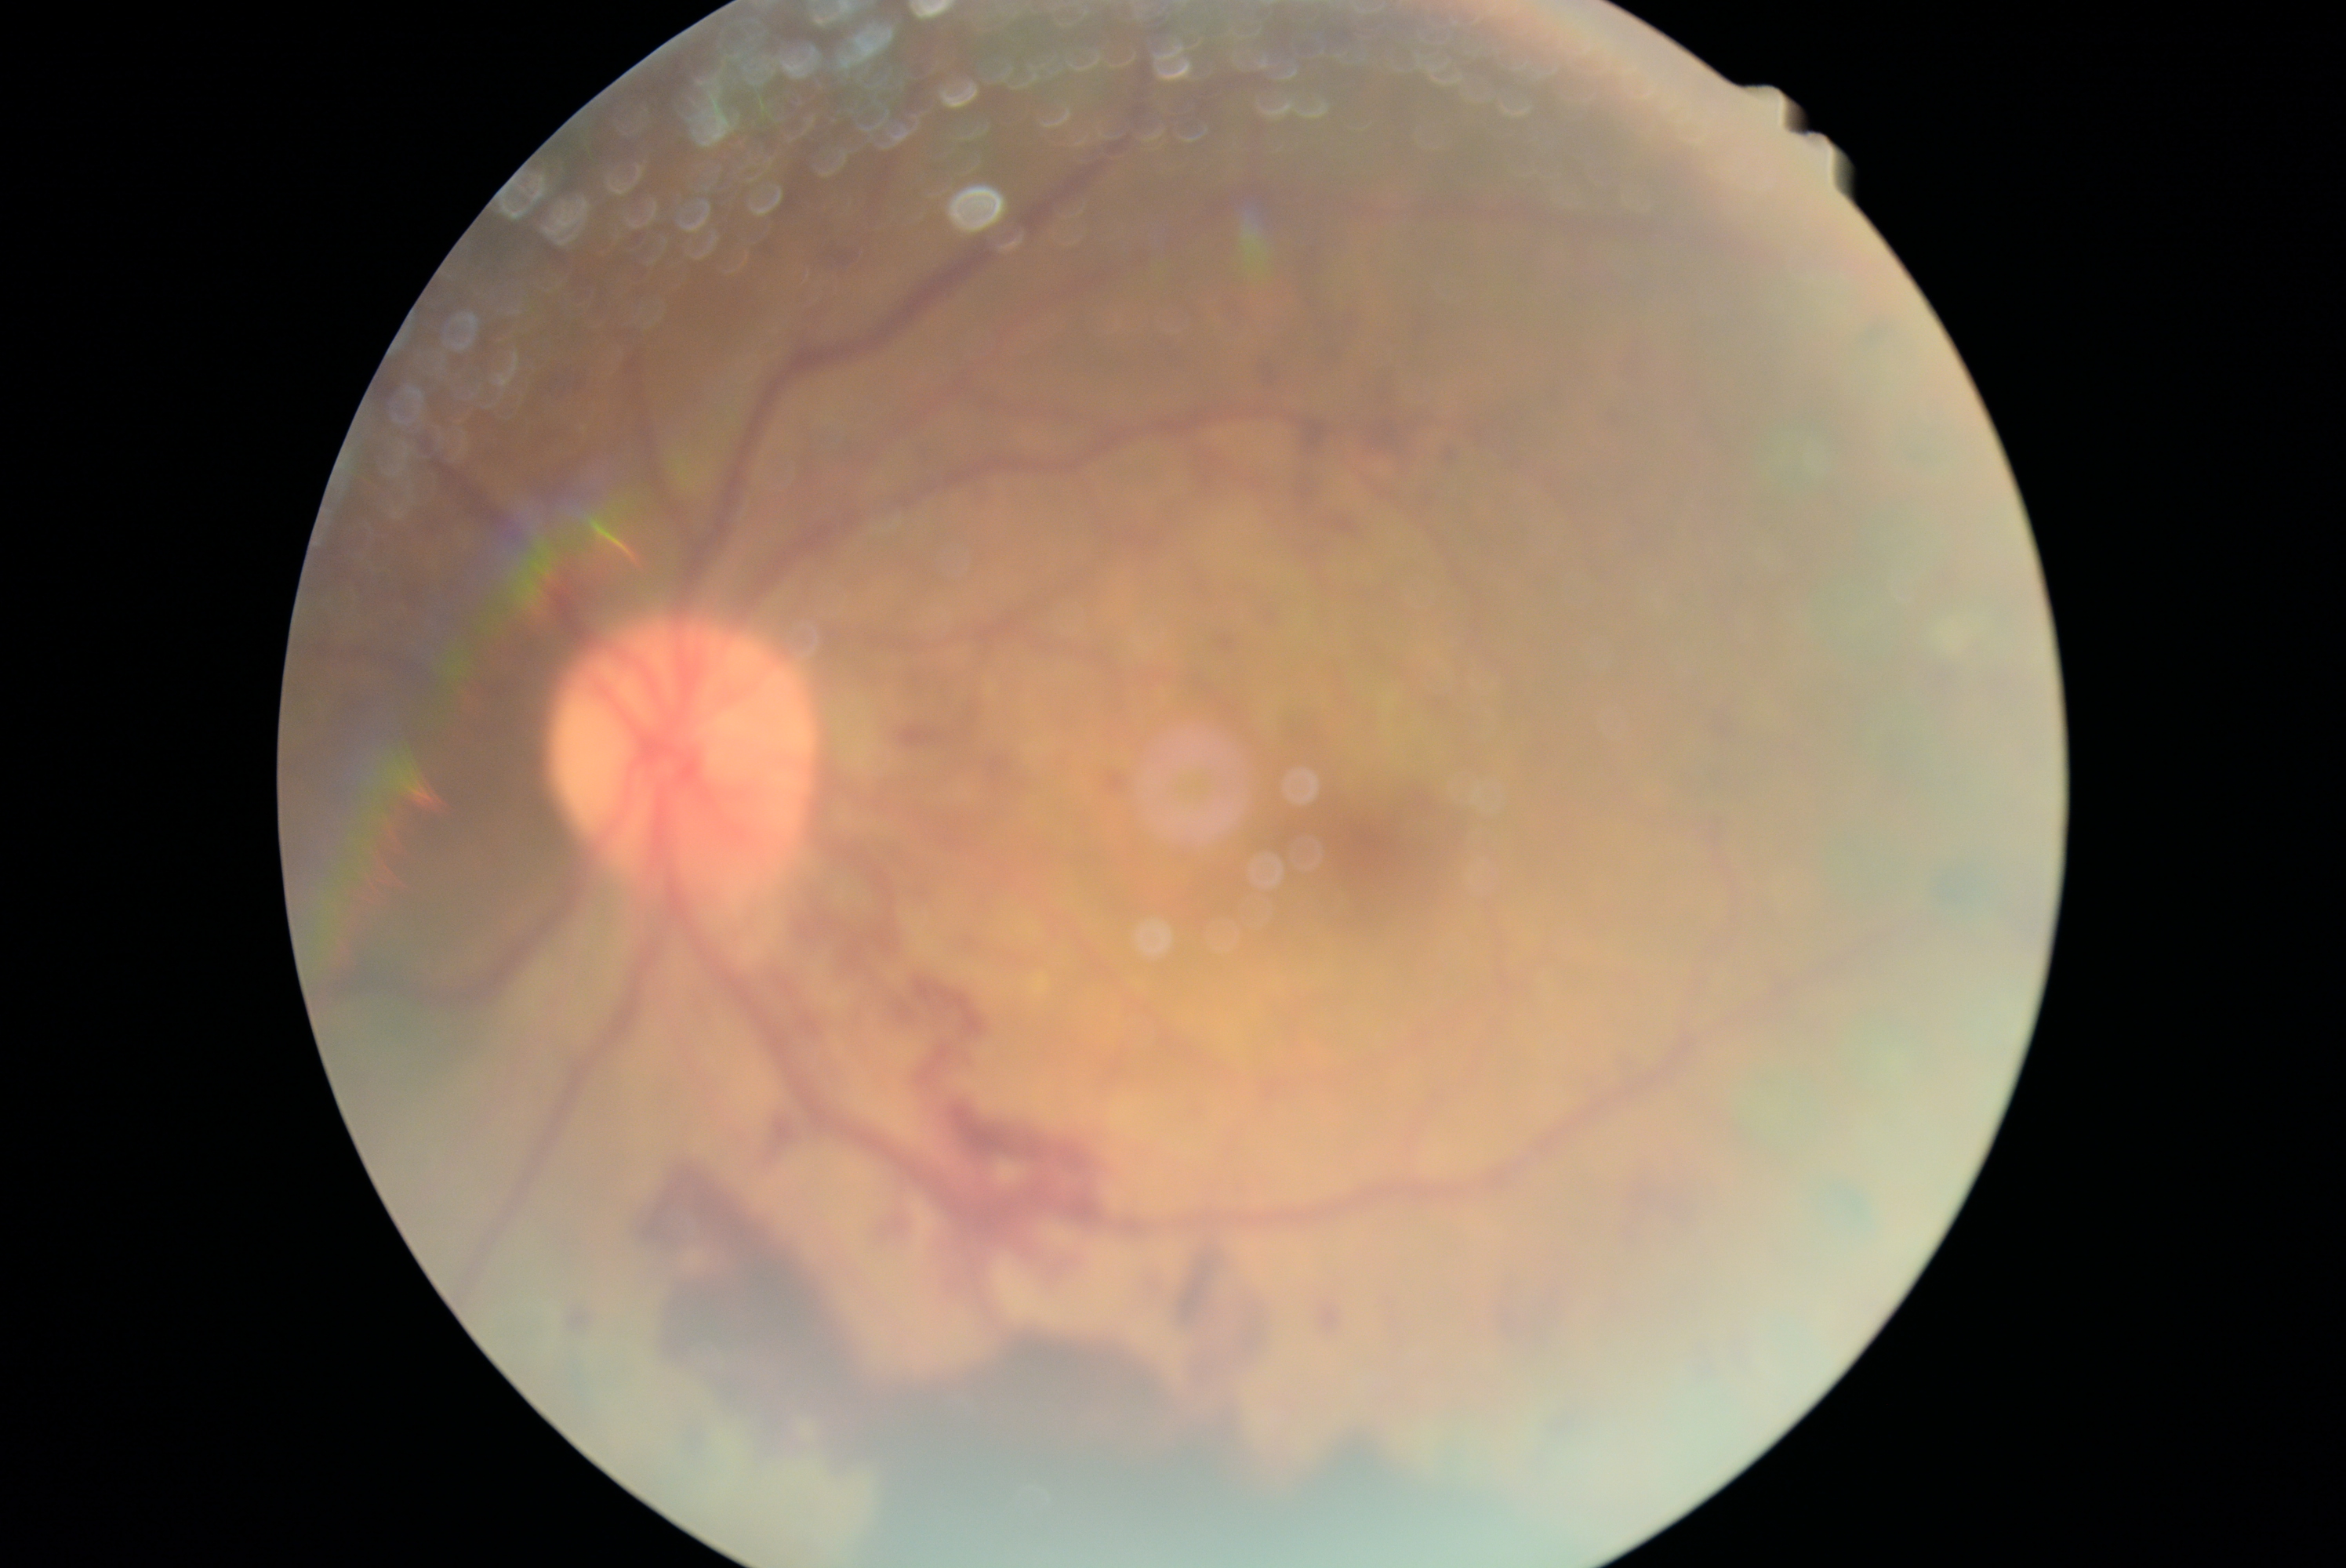

DR = 4/4.